FOV: 45 degrees · retinal fundus photograph · image size 2352x1568
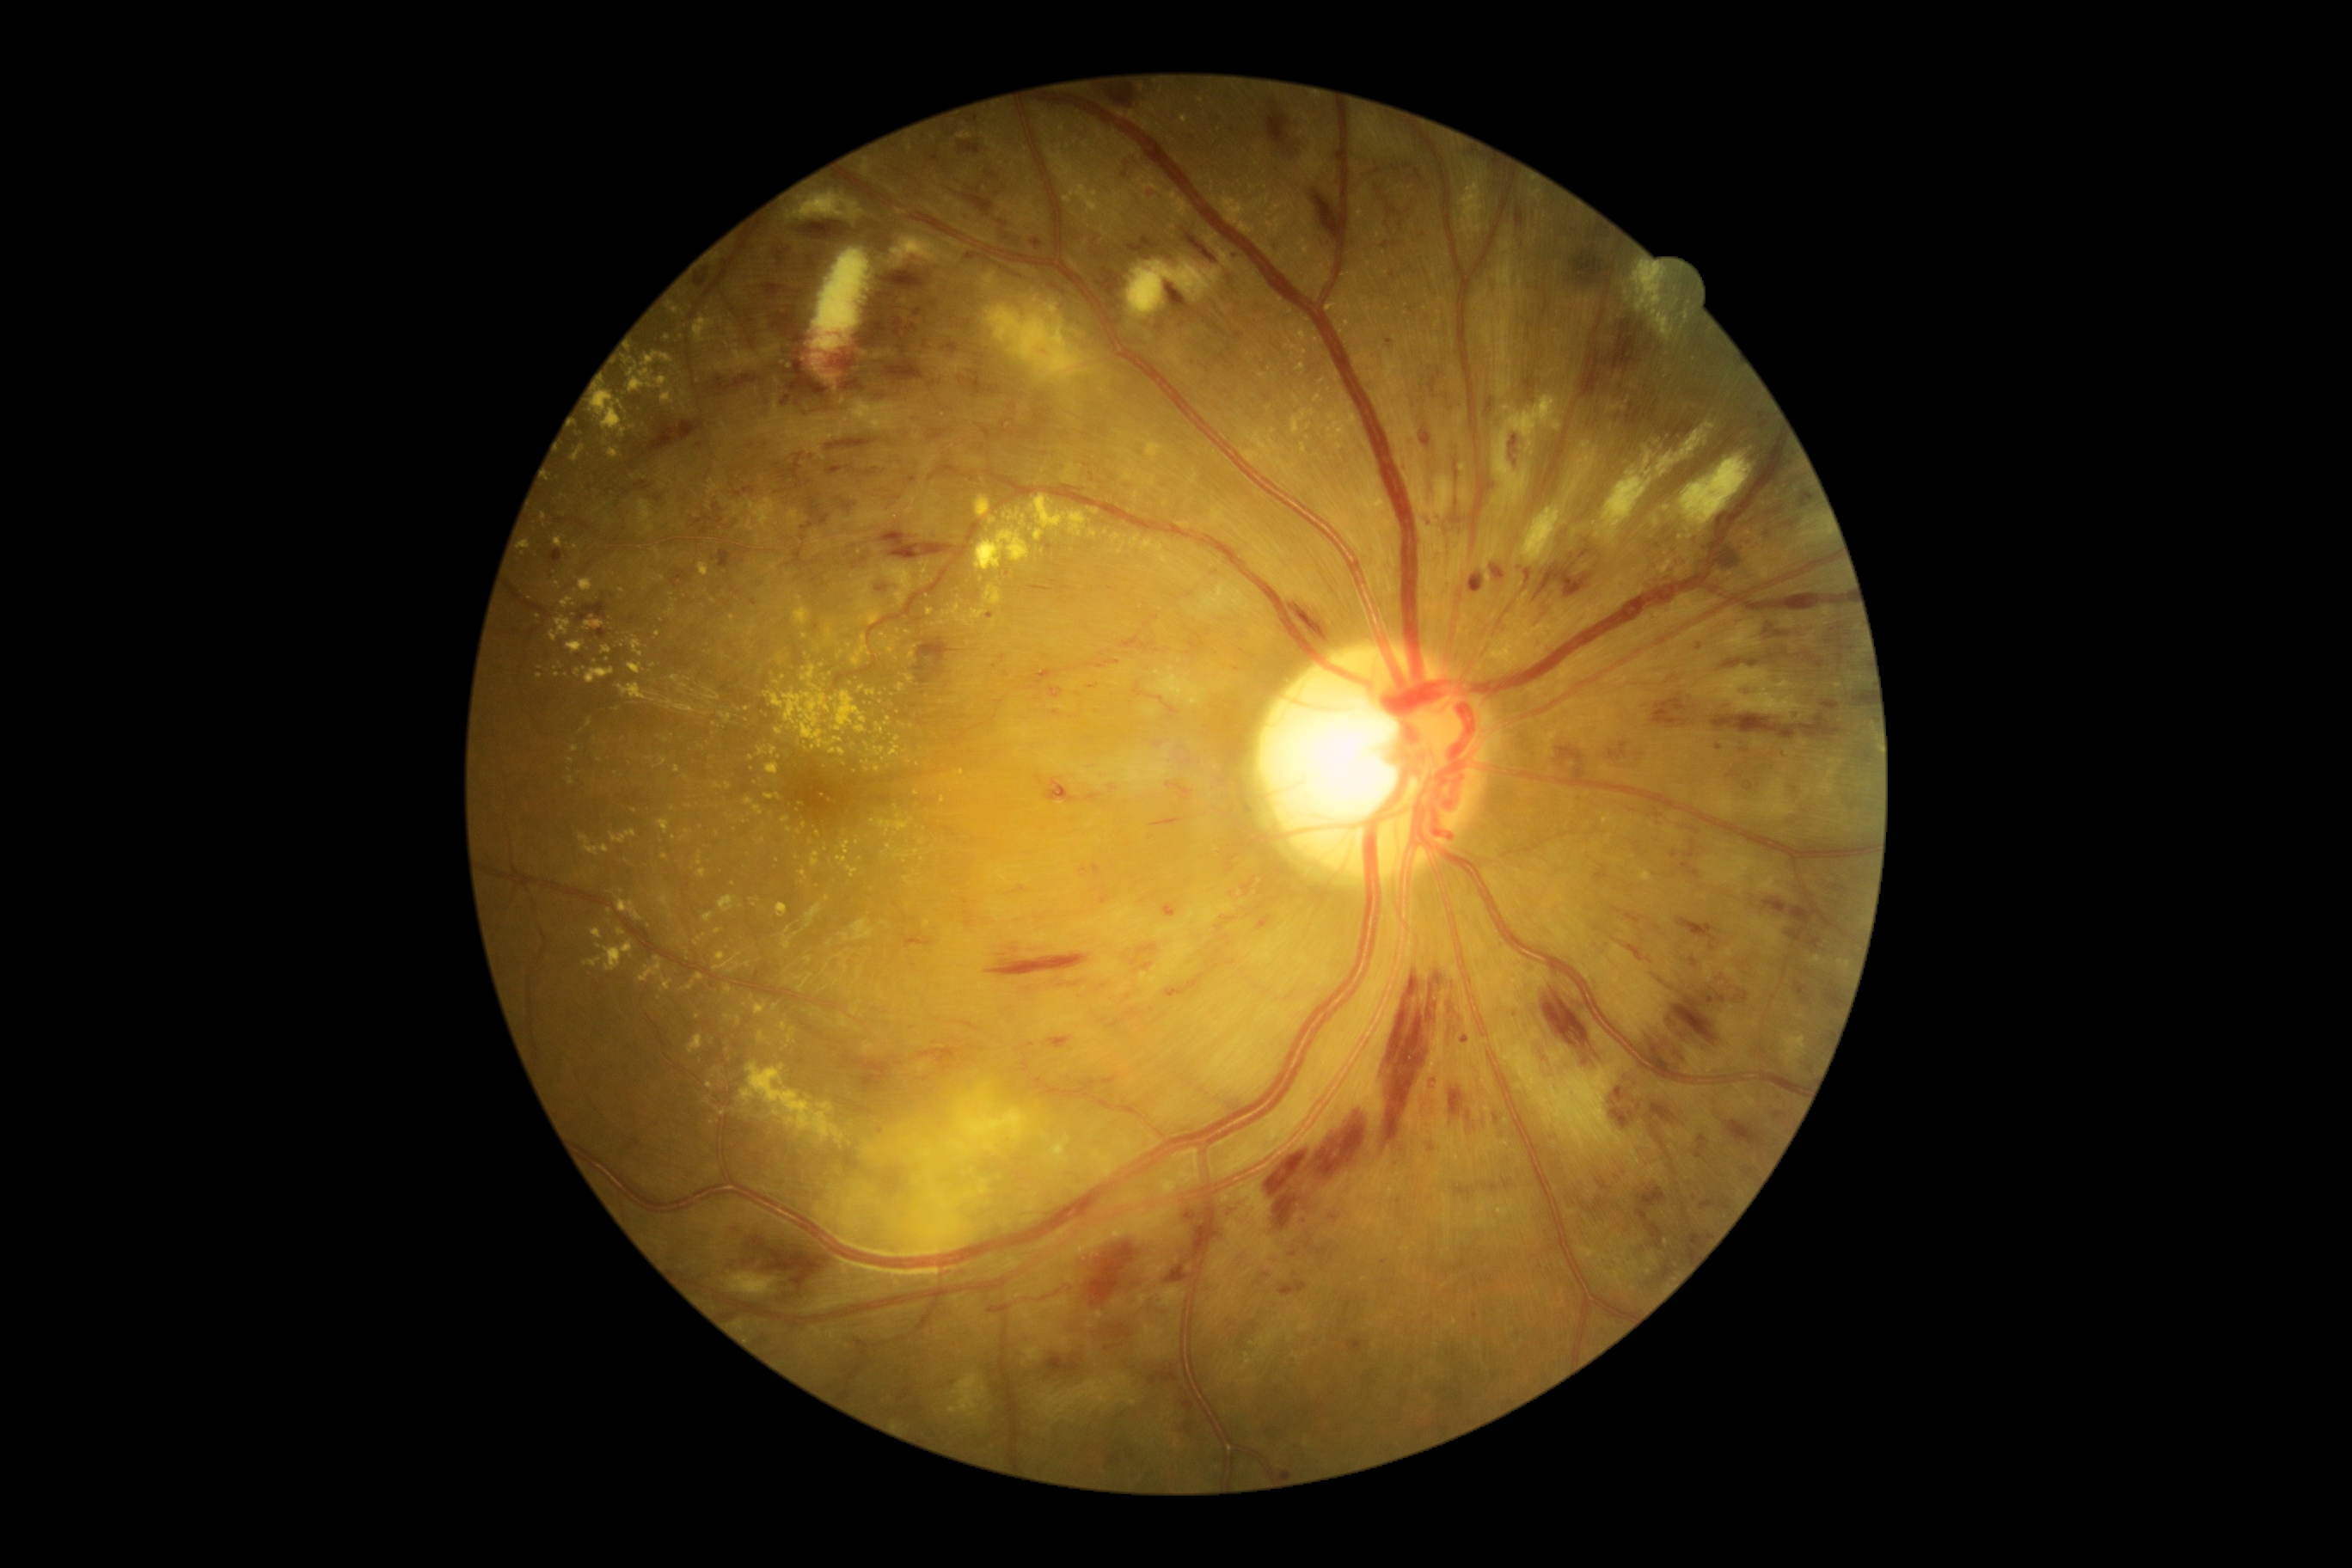

DR stage is 3.